45° FOV
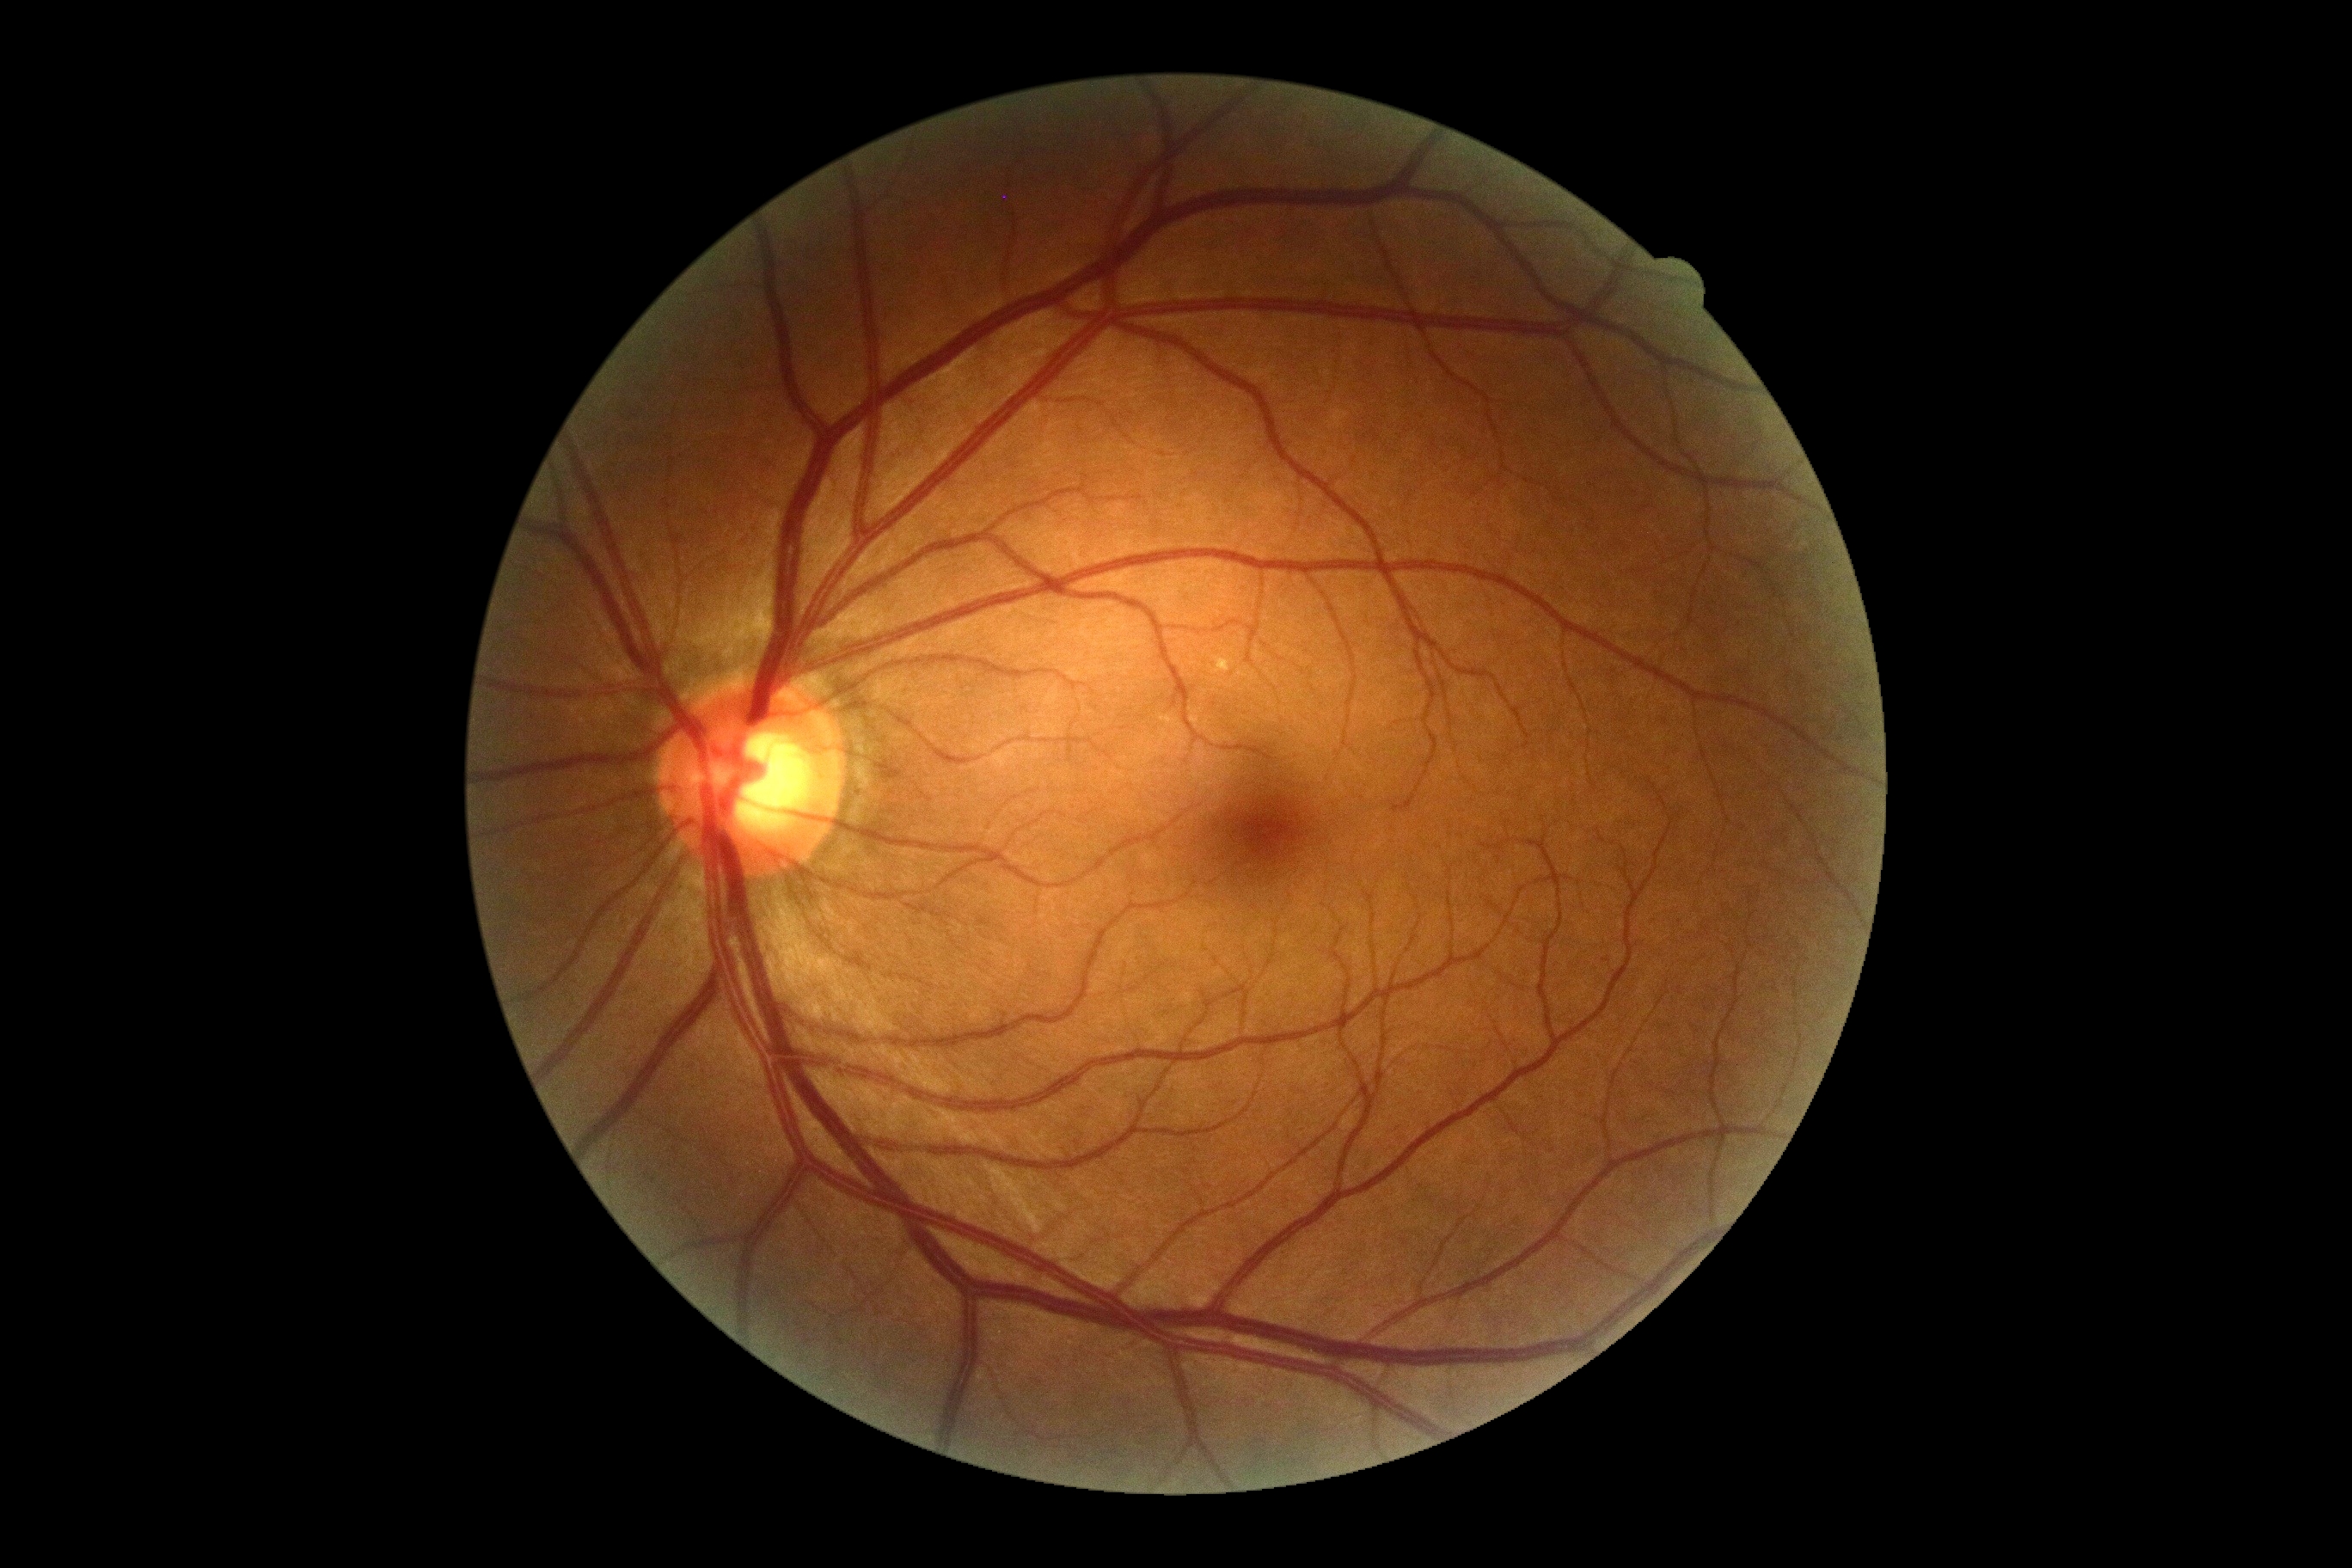
Findings:
* DR stage: 0 — no visible signs of diabetic retinopathy
* DR impression: no signs of DR